2352 by 1568 pixels: 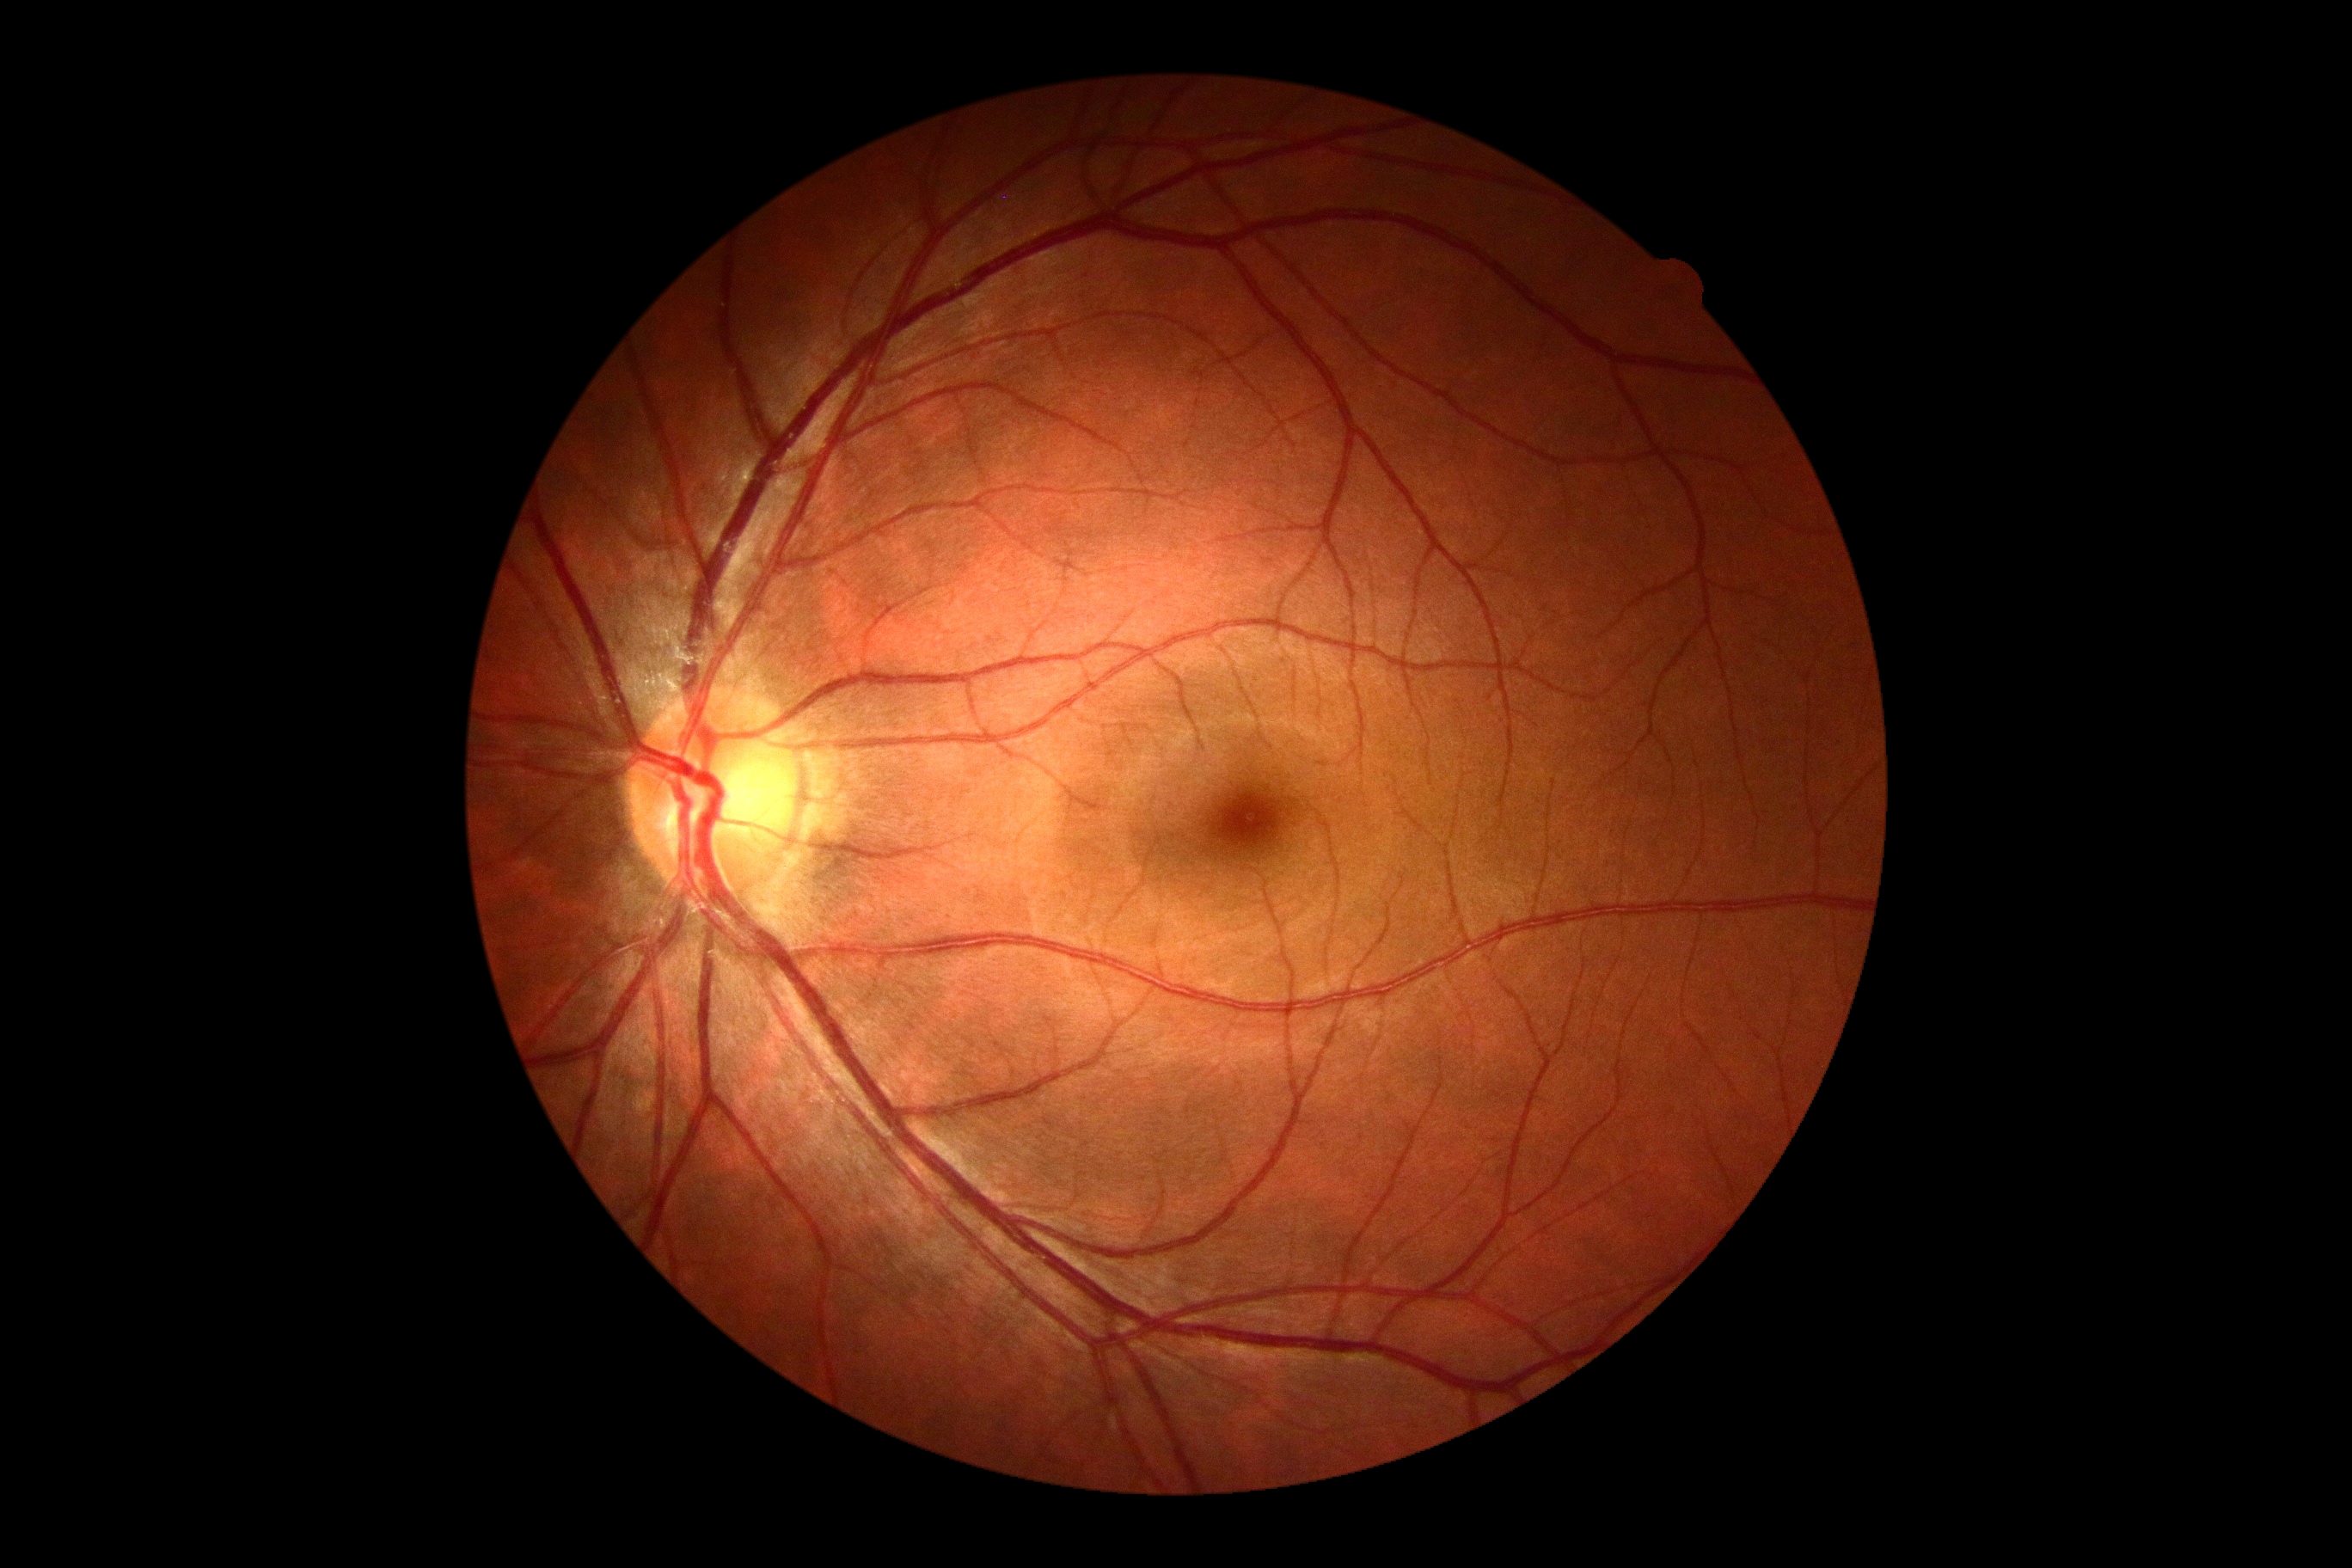

– retinopathy grade — no apparent retinopathy (0)
– DR impression — no apparent DR